2352x1568 · FOV: 45 degrees · color fundus photograph: 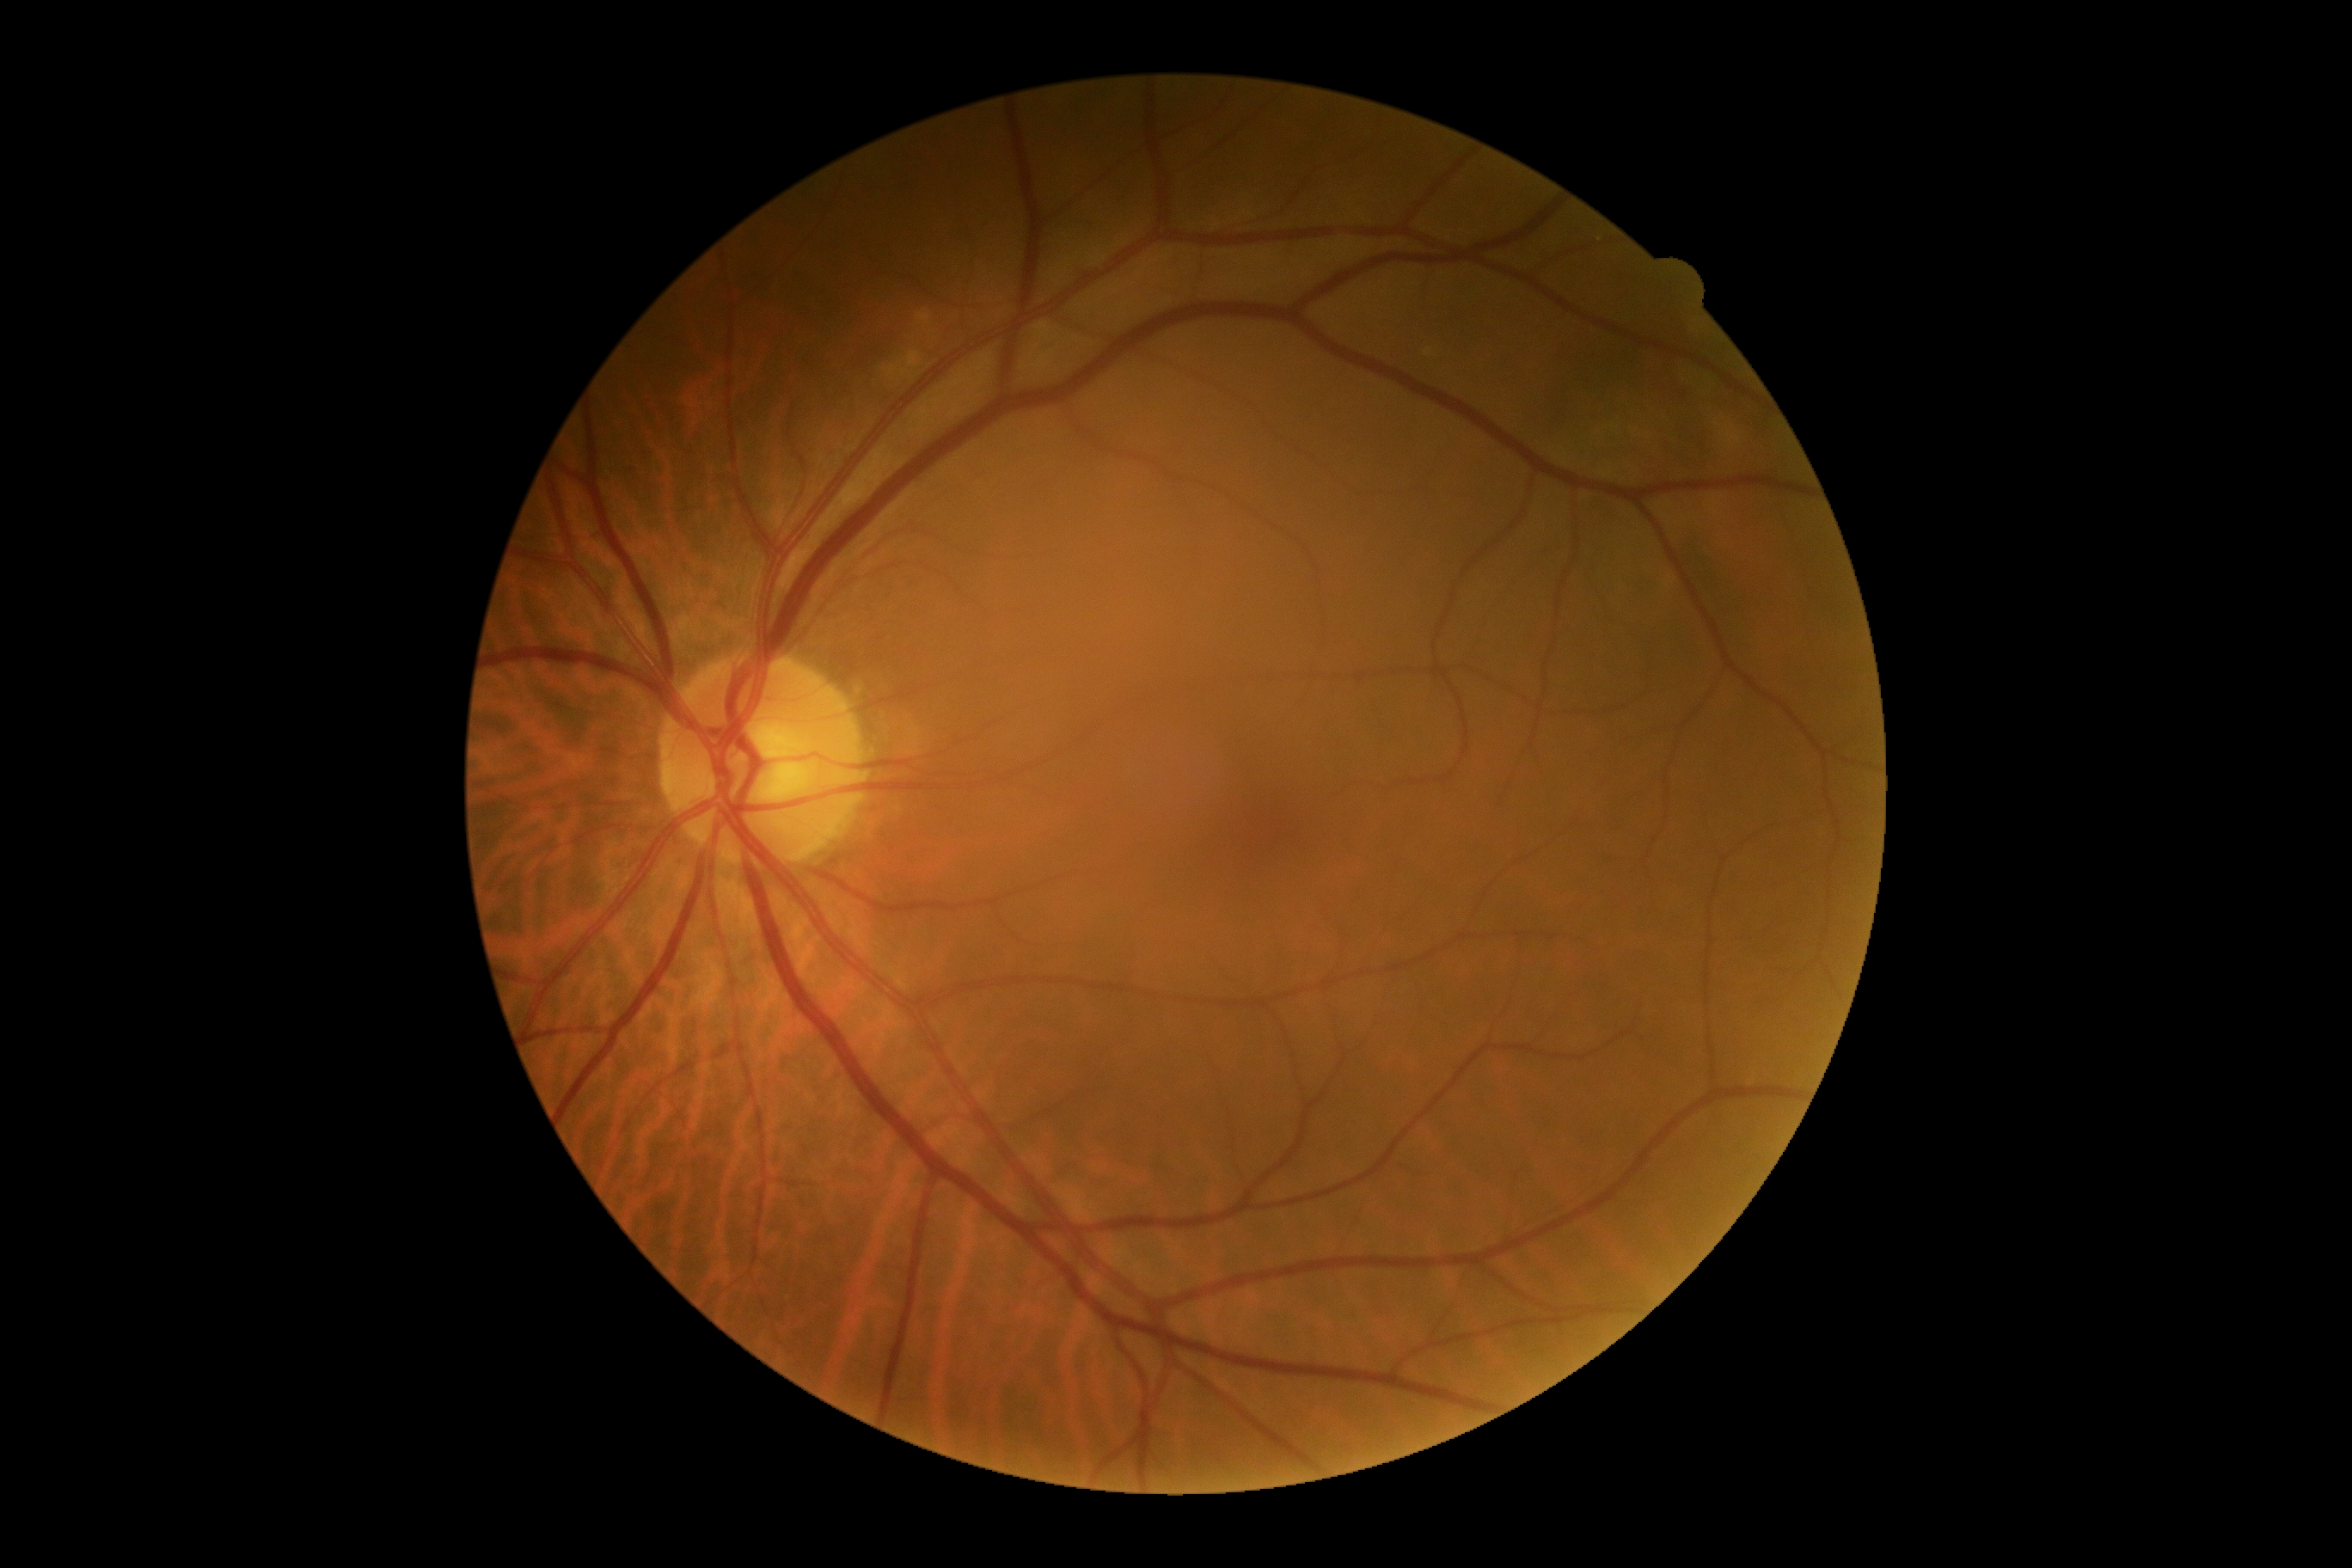

dr_grade: 0